848x848; modified Davis classification; color fundus photograph:
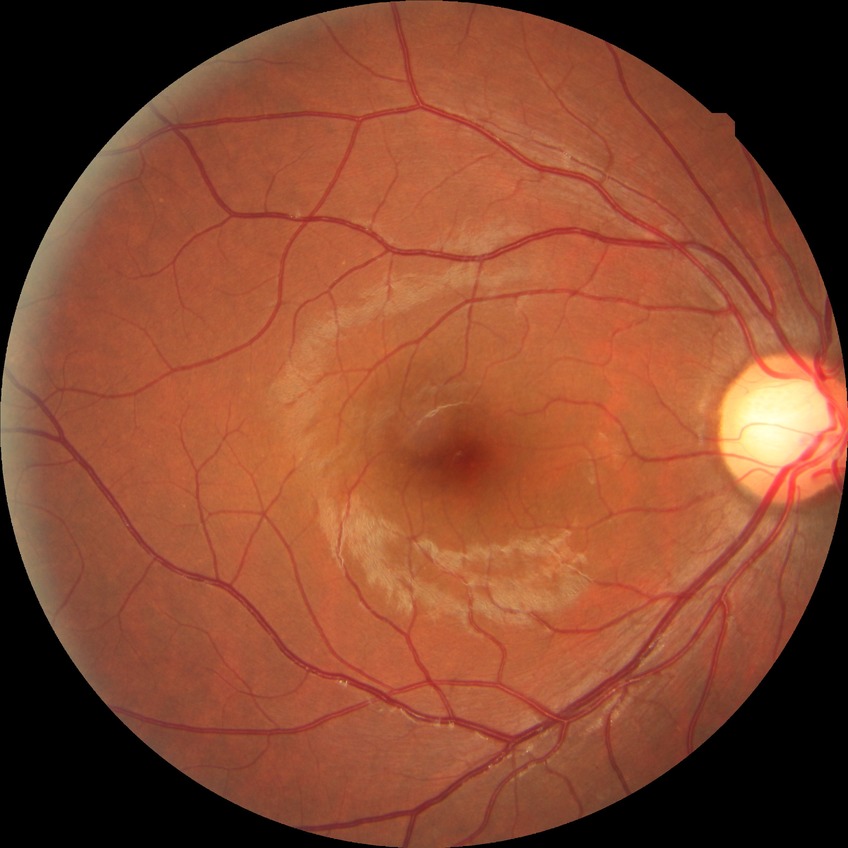 Diabetic retinopathy grade: no diabetic retinopathy.